CFP.
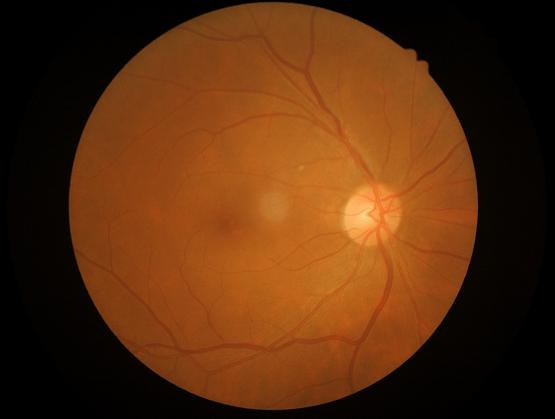
  contrast: good dynamic range
  clarity: optic disc, vessels, and background in focus
  overall_quality: adequate for clinical interpretation